Image size 848x848 — 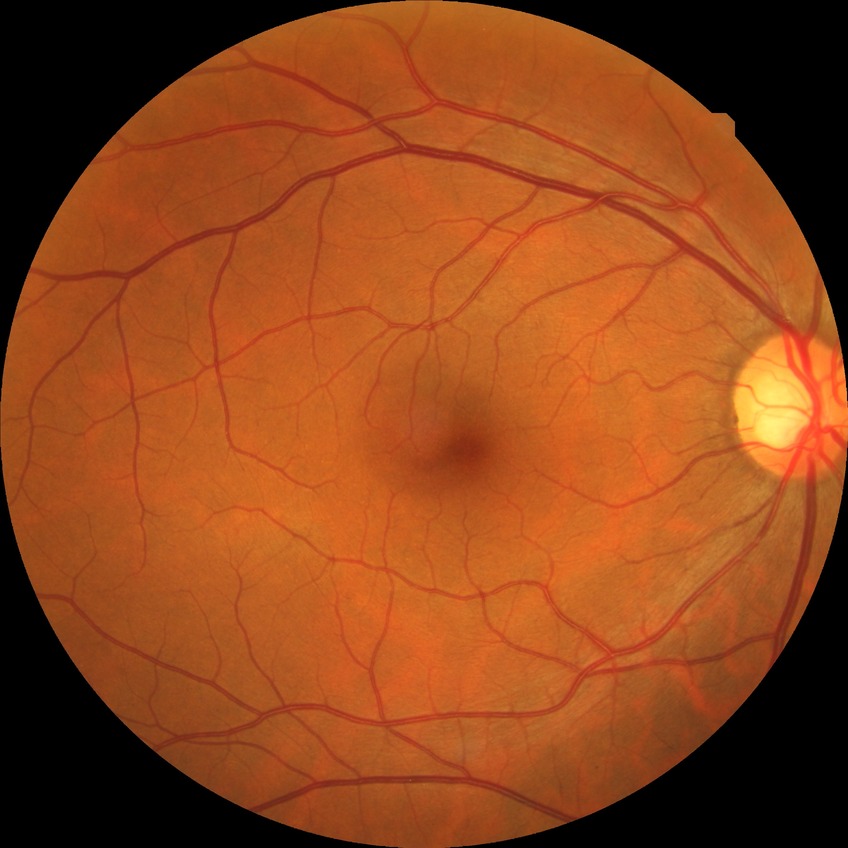
Diabetic retinopathy (DR) is no diabetic retinopathy (NDR).